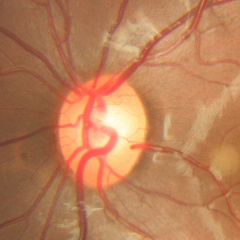

Q: Is glaucoma present?
A: No signs of glaucoma.